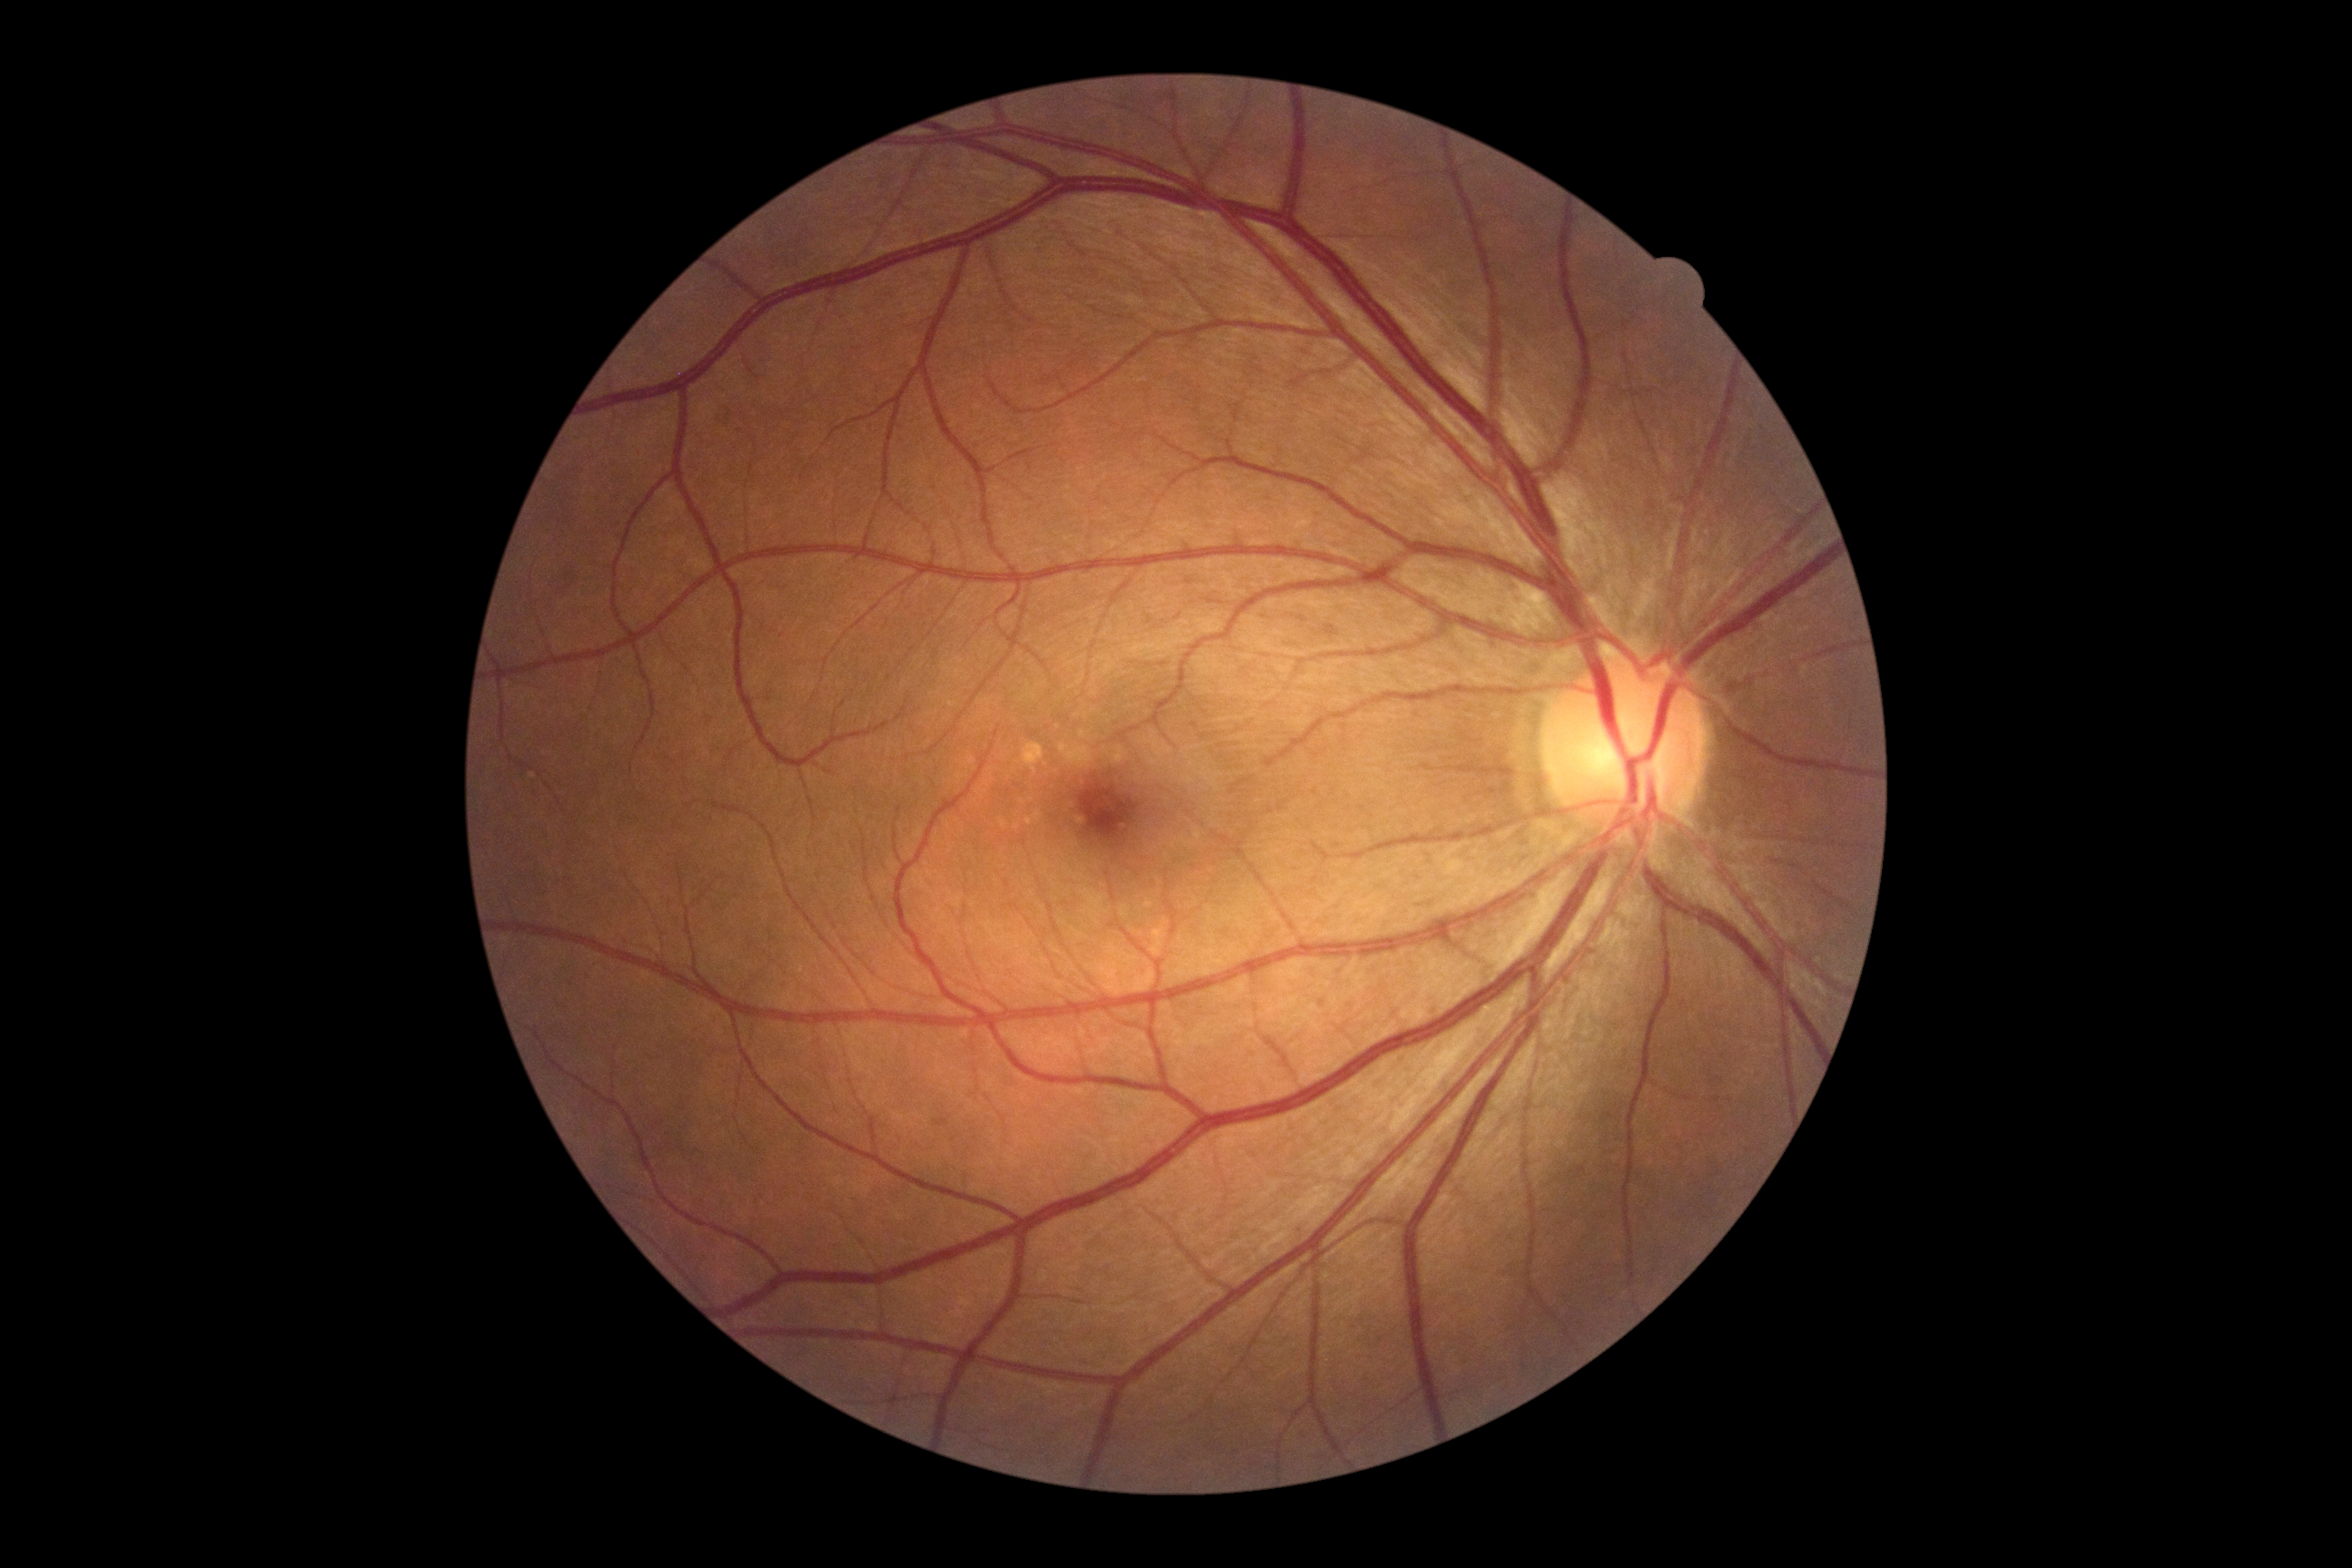
Diabetic retinopathy severity is 0/4 — no visible signs of diabetic retinopathy. No DR findings.